Retinal fundus photograph:
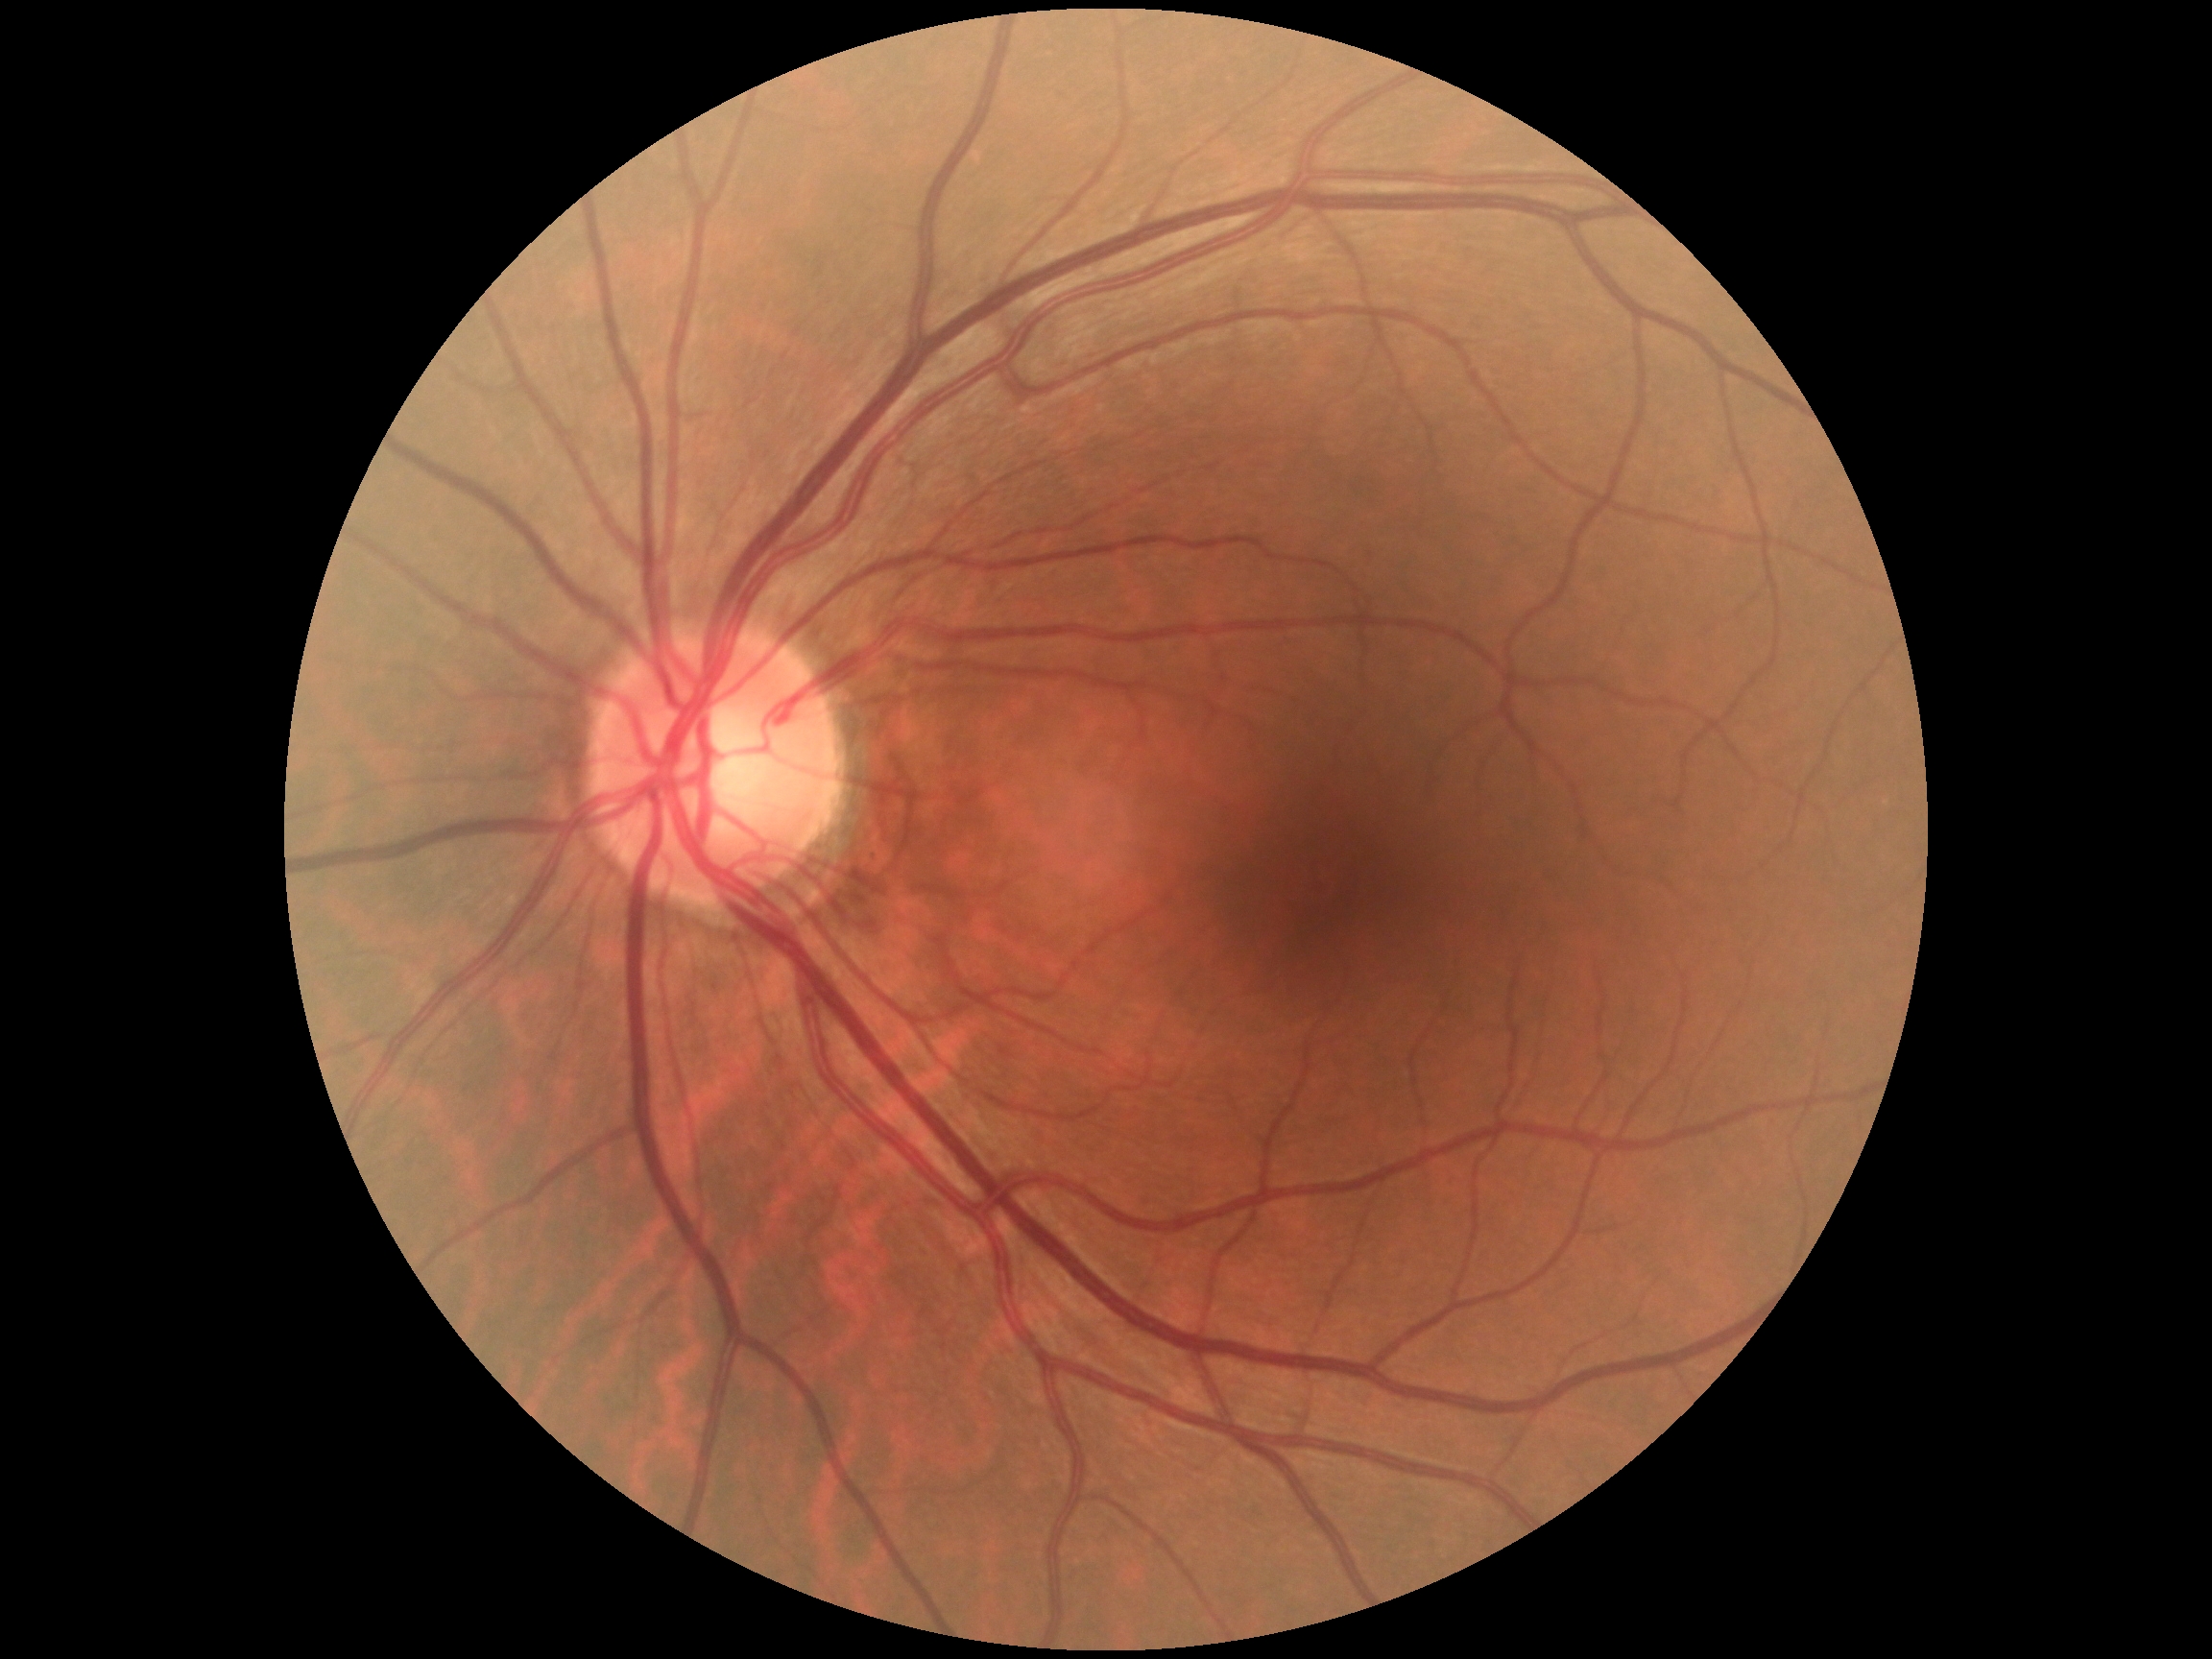

No signs of diabetic retinopathy.
Diabetic retinopathy is grade 0 (no apparent retinopathy).